Retinal fundus photograph
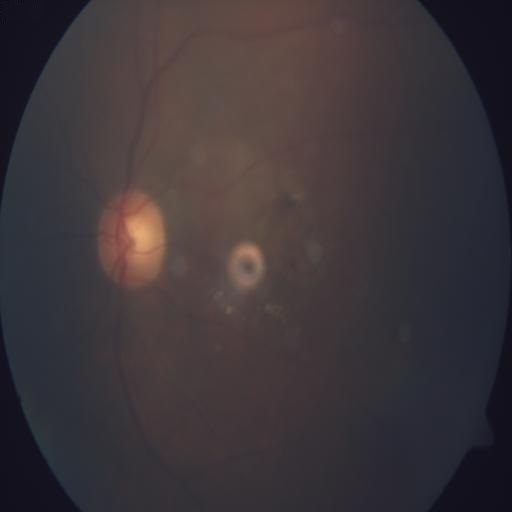 Impression:
- media haze